Fundus photo:
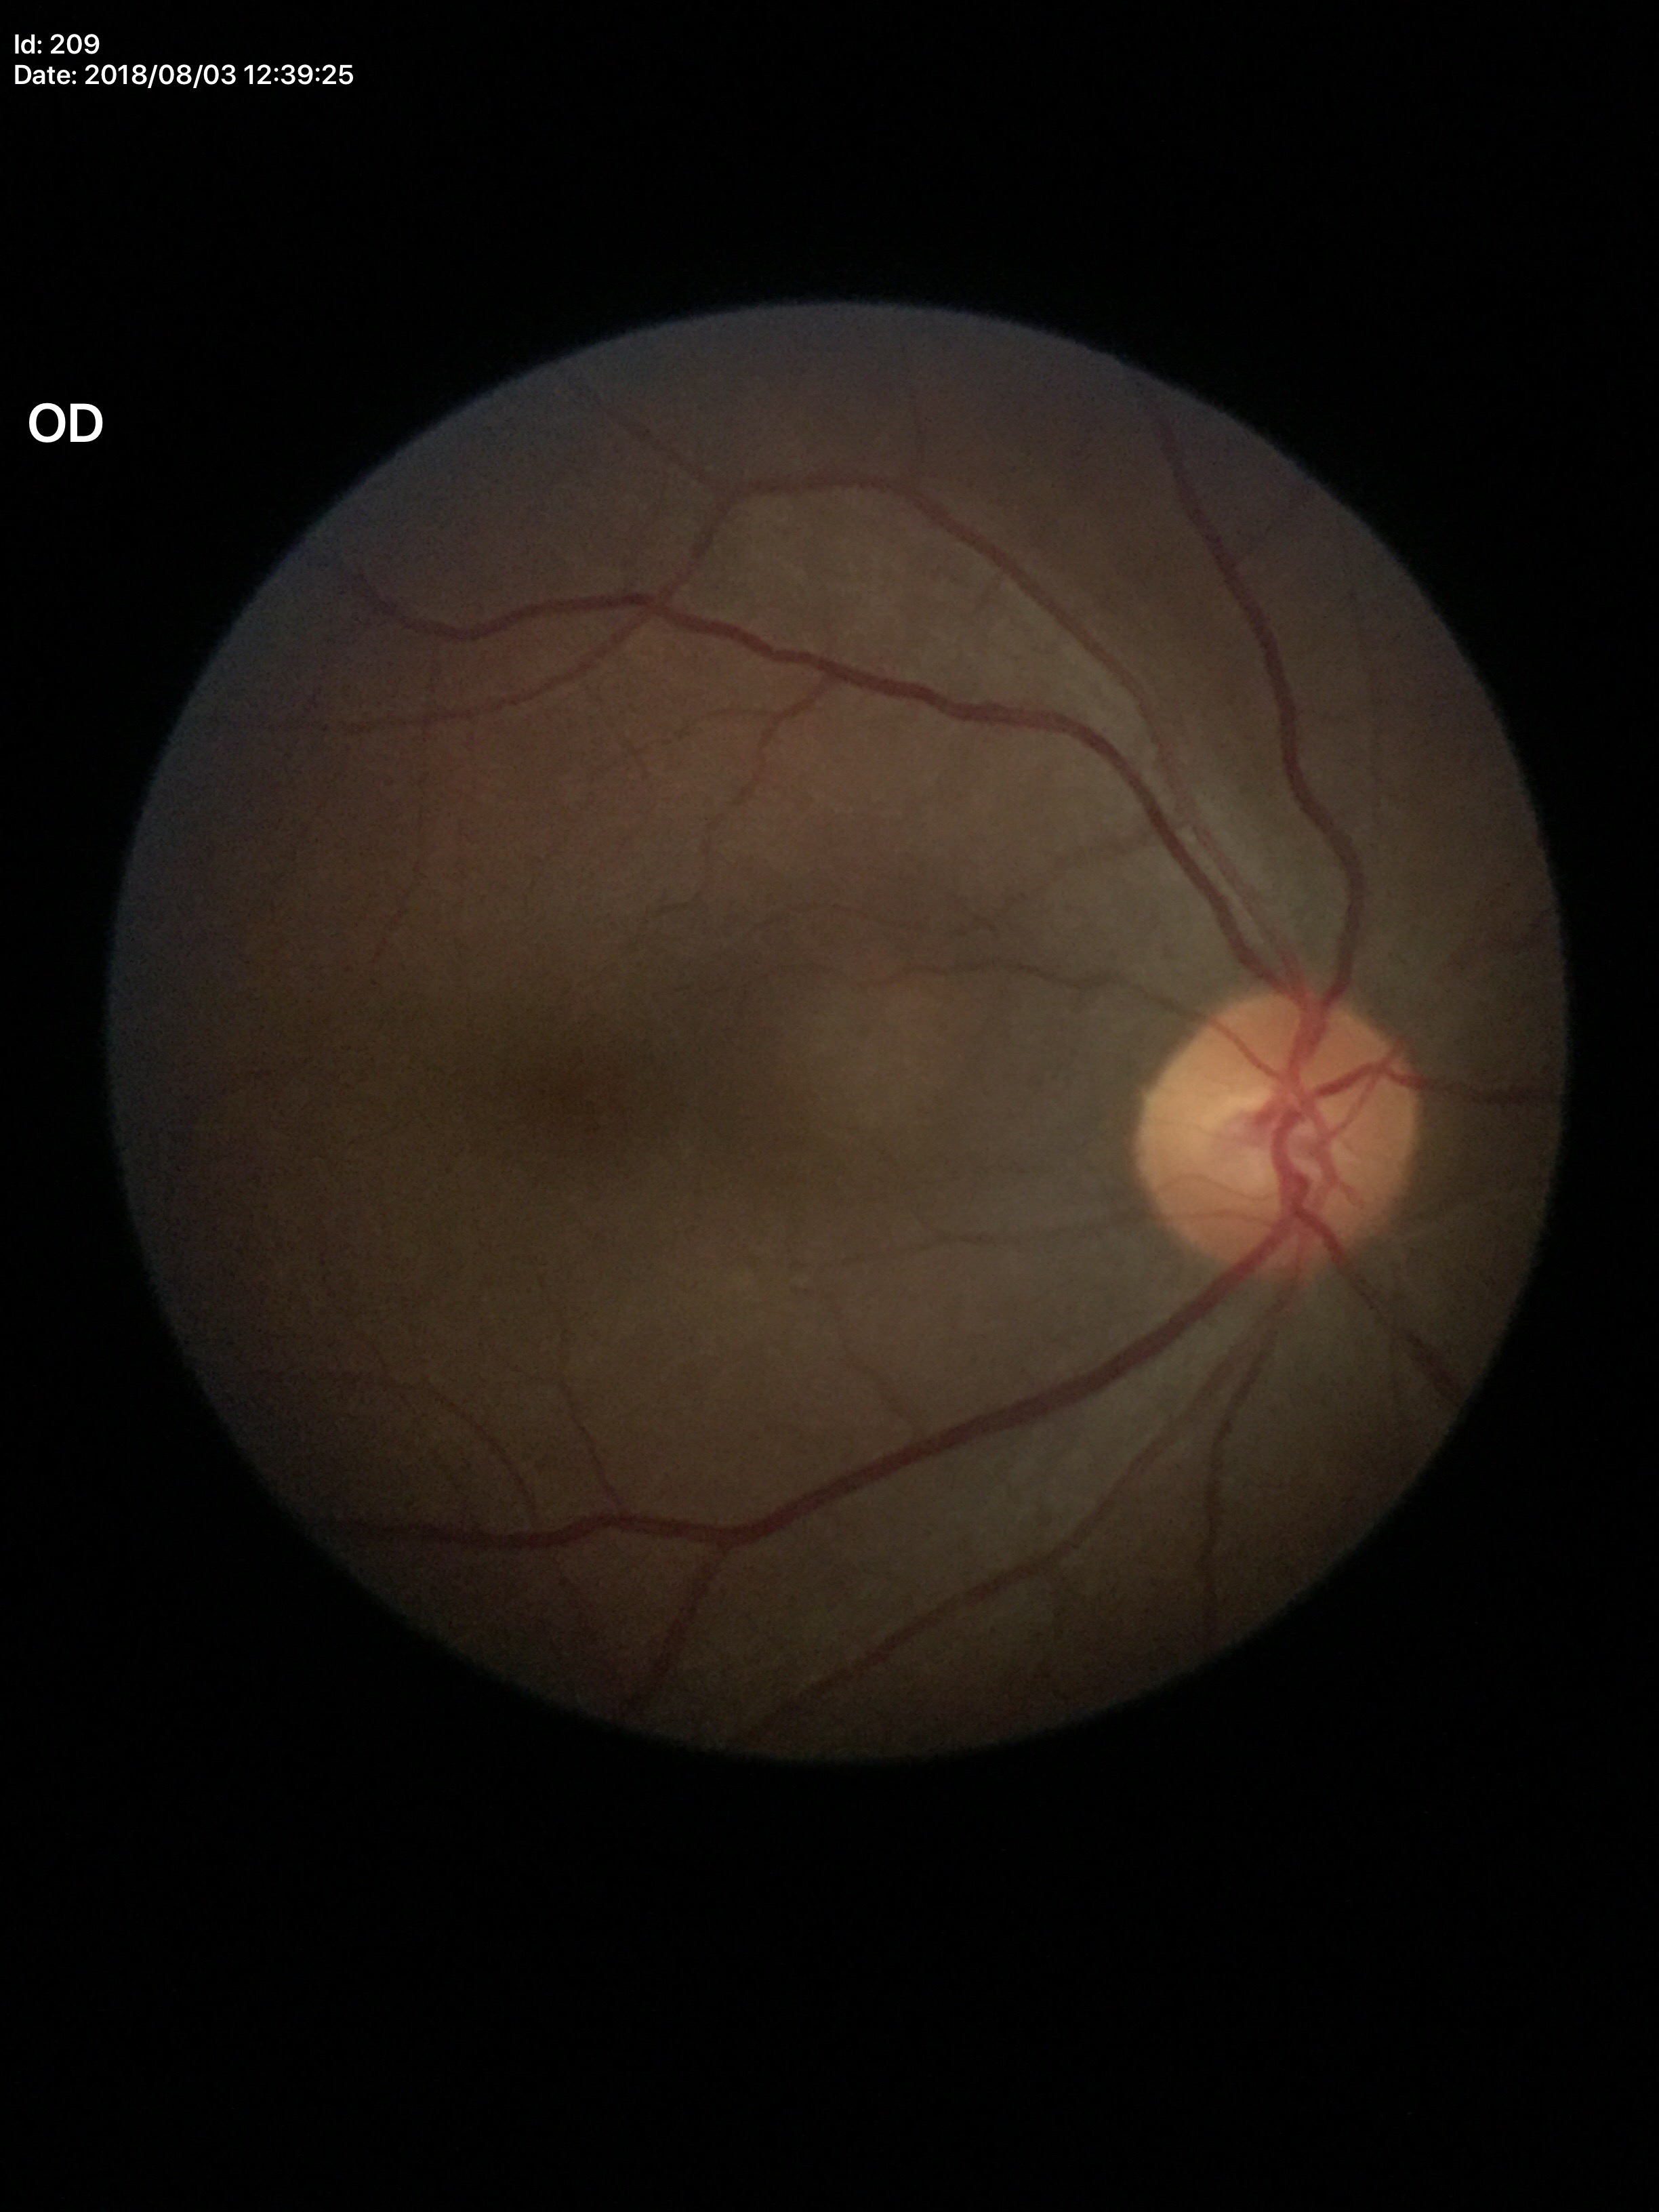
Glaucoma decision: no suspicious findings; VCDR: 0.48.